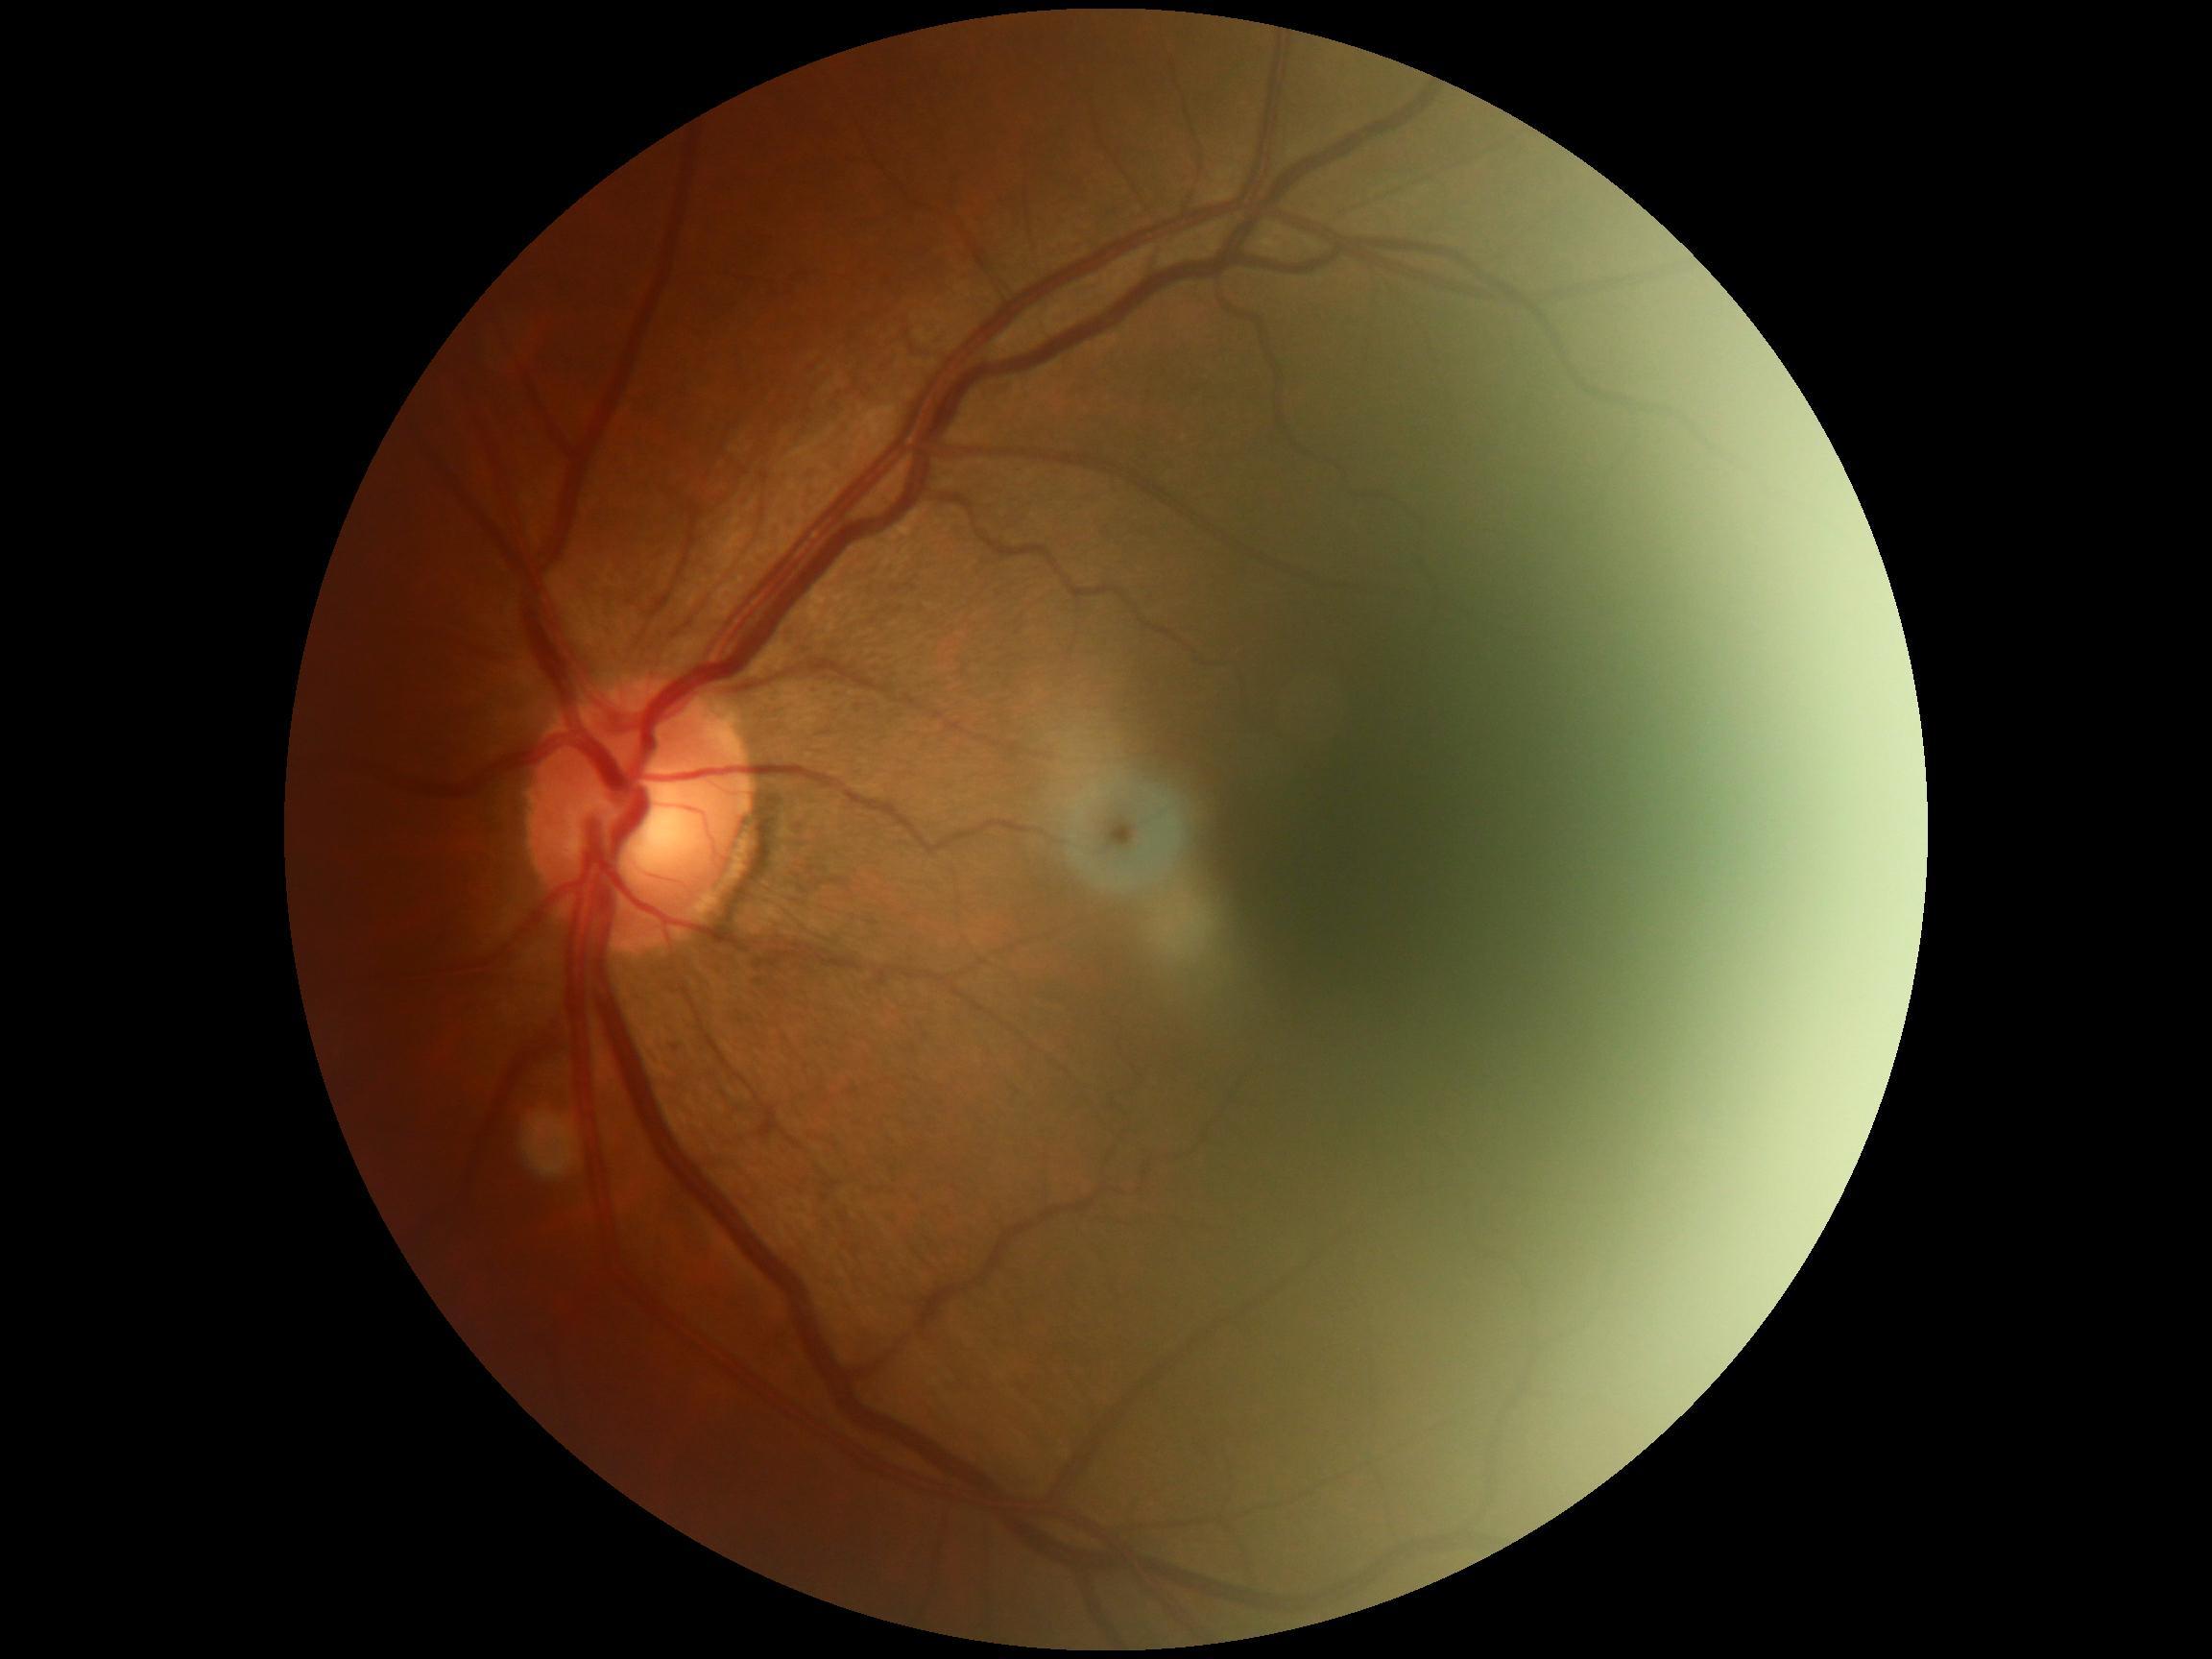
DR severity: grade 0 (no apparent retinopathy).
No apparent diabetic retinopathy.